Infant wide-field retinal image. 640x480px
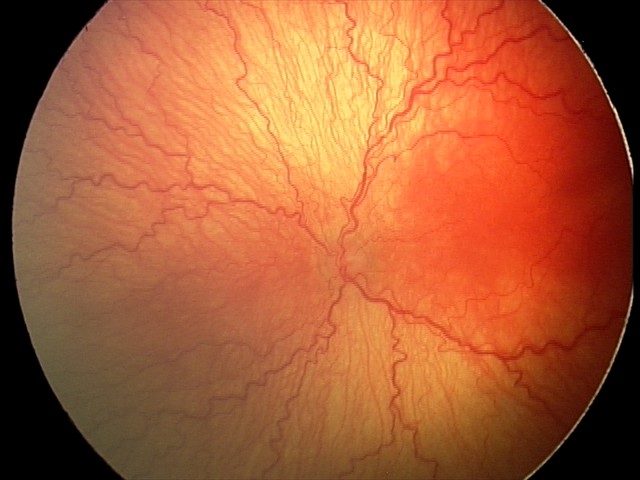
Q: What is the screening diagnosis?
A: aggressive retinopathy of prematurity
Q: Plus disease status?
A: plus disease